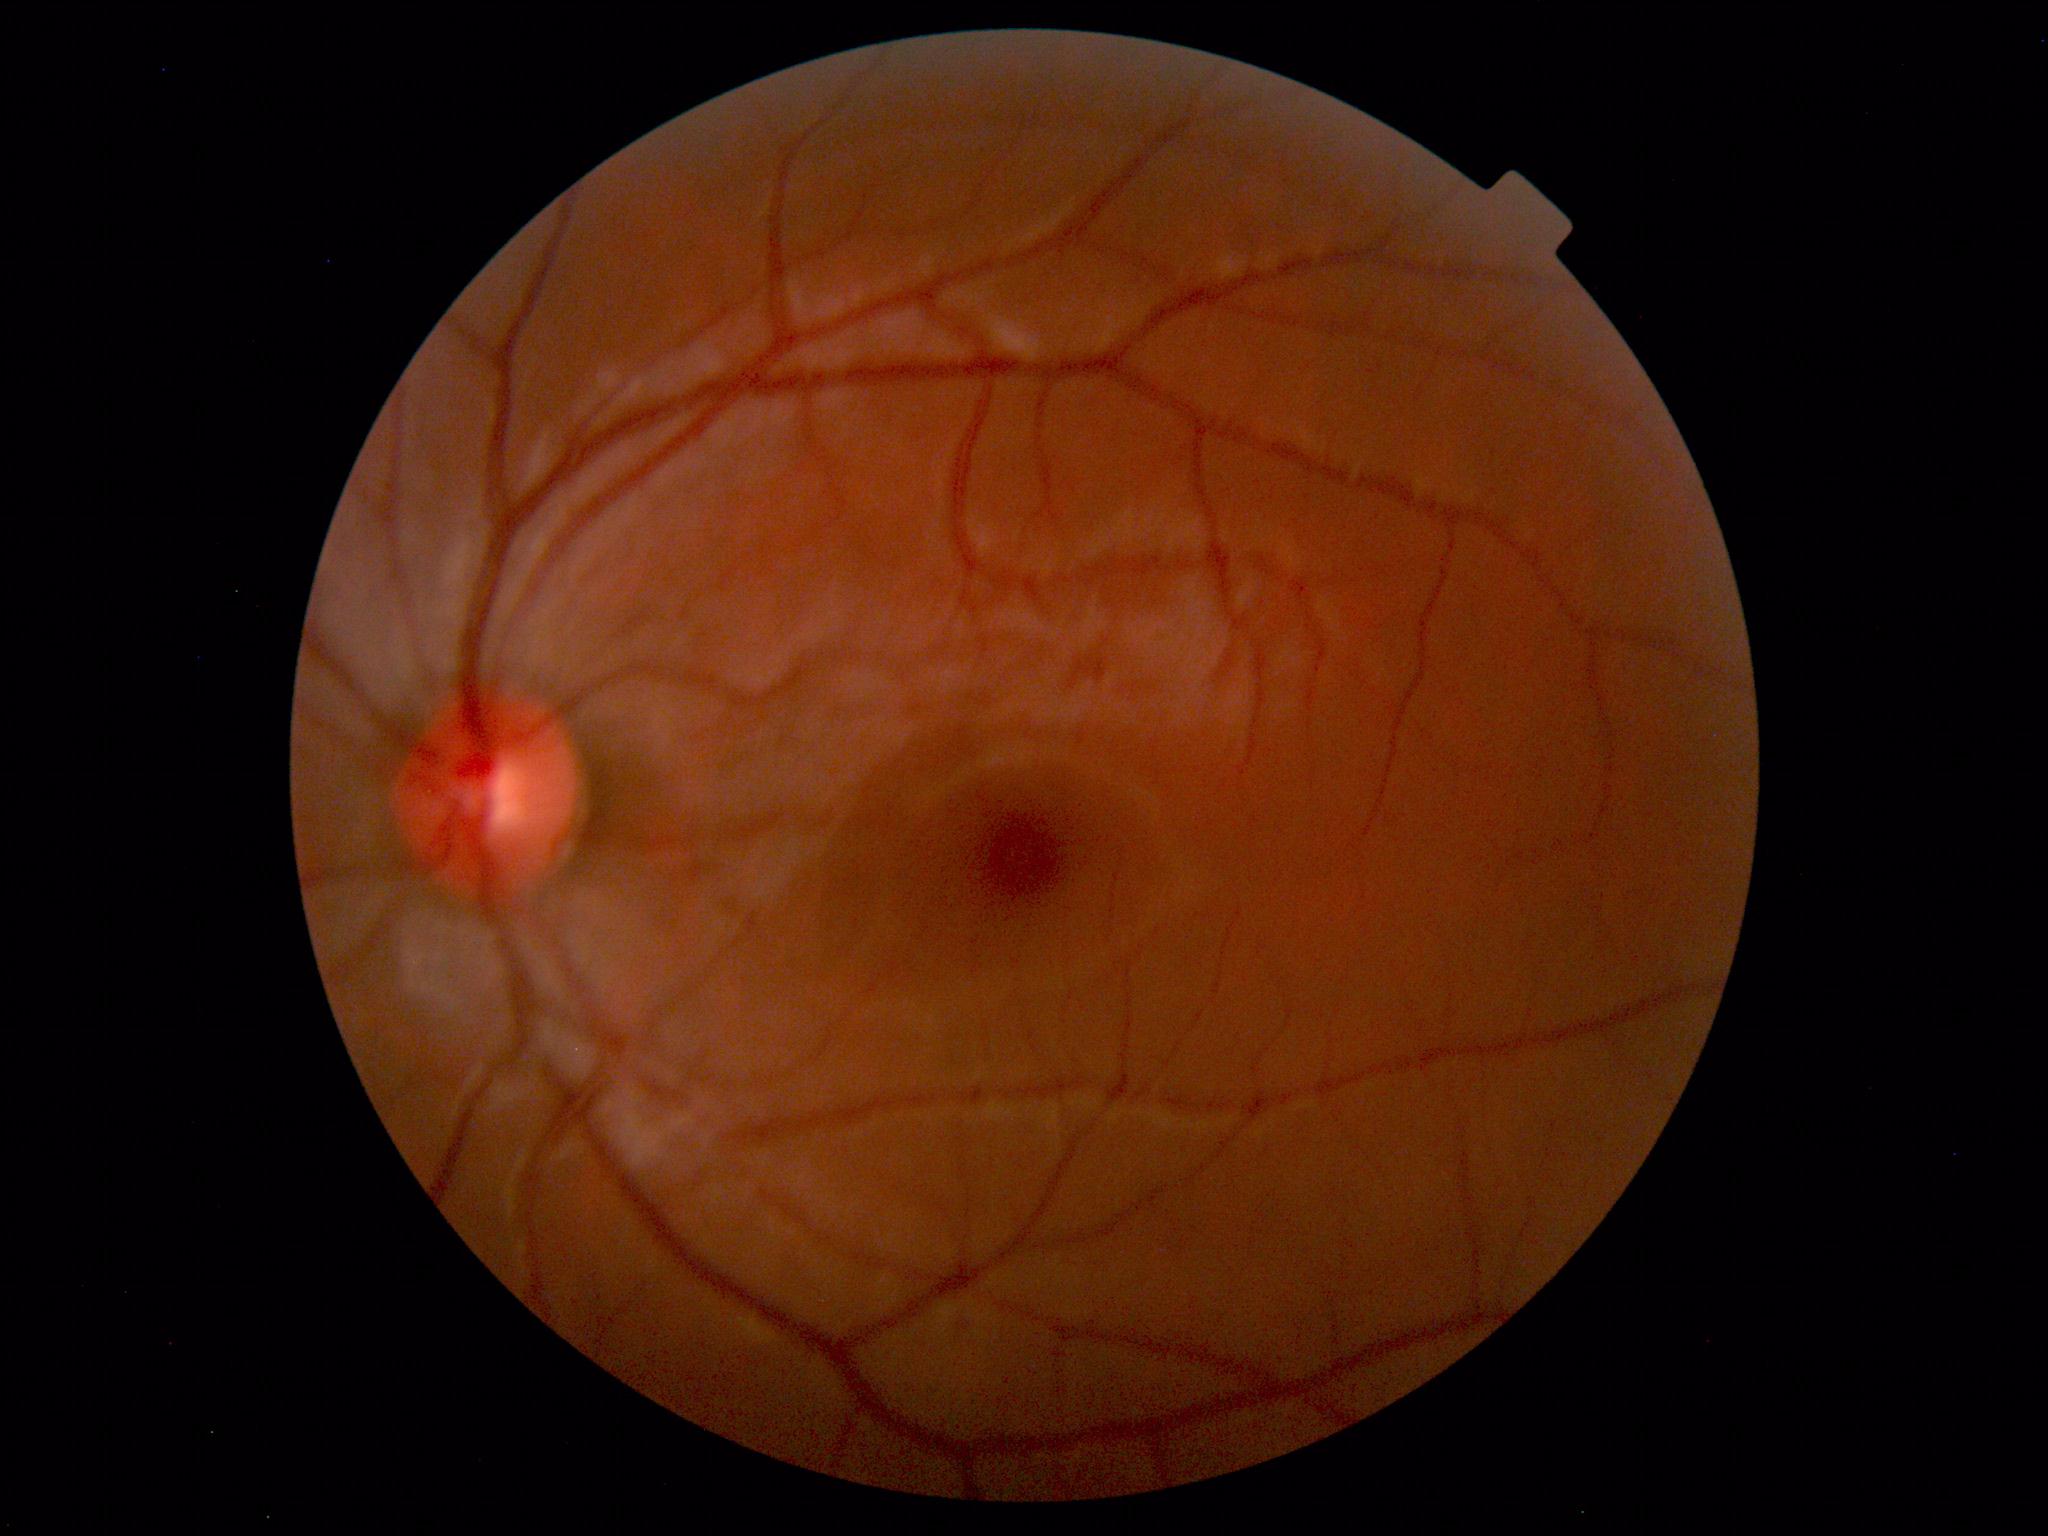 Normal retinal fundus image with no abnormalities identified.